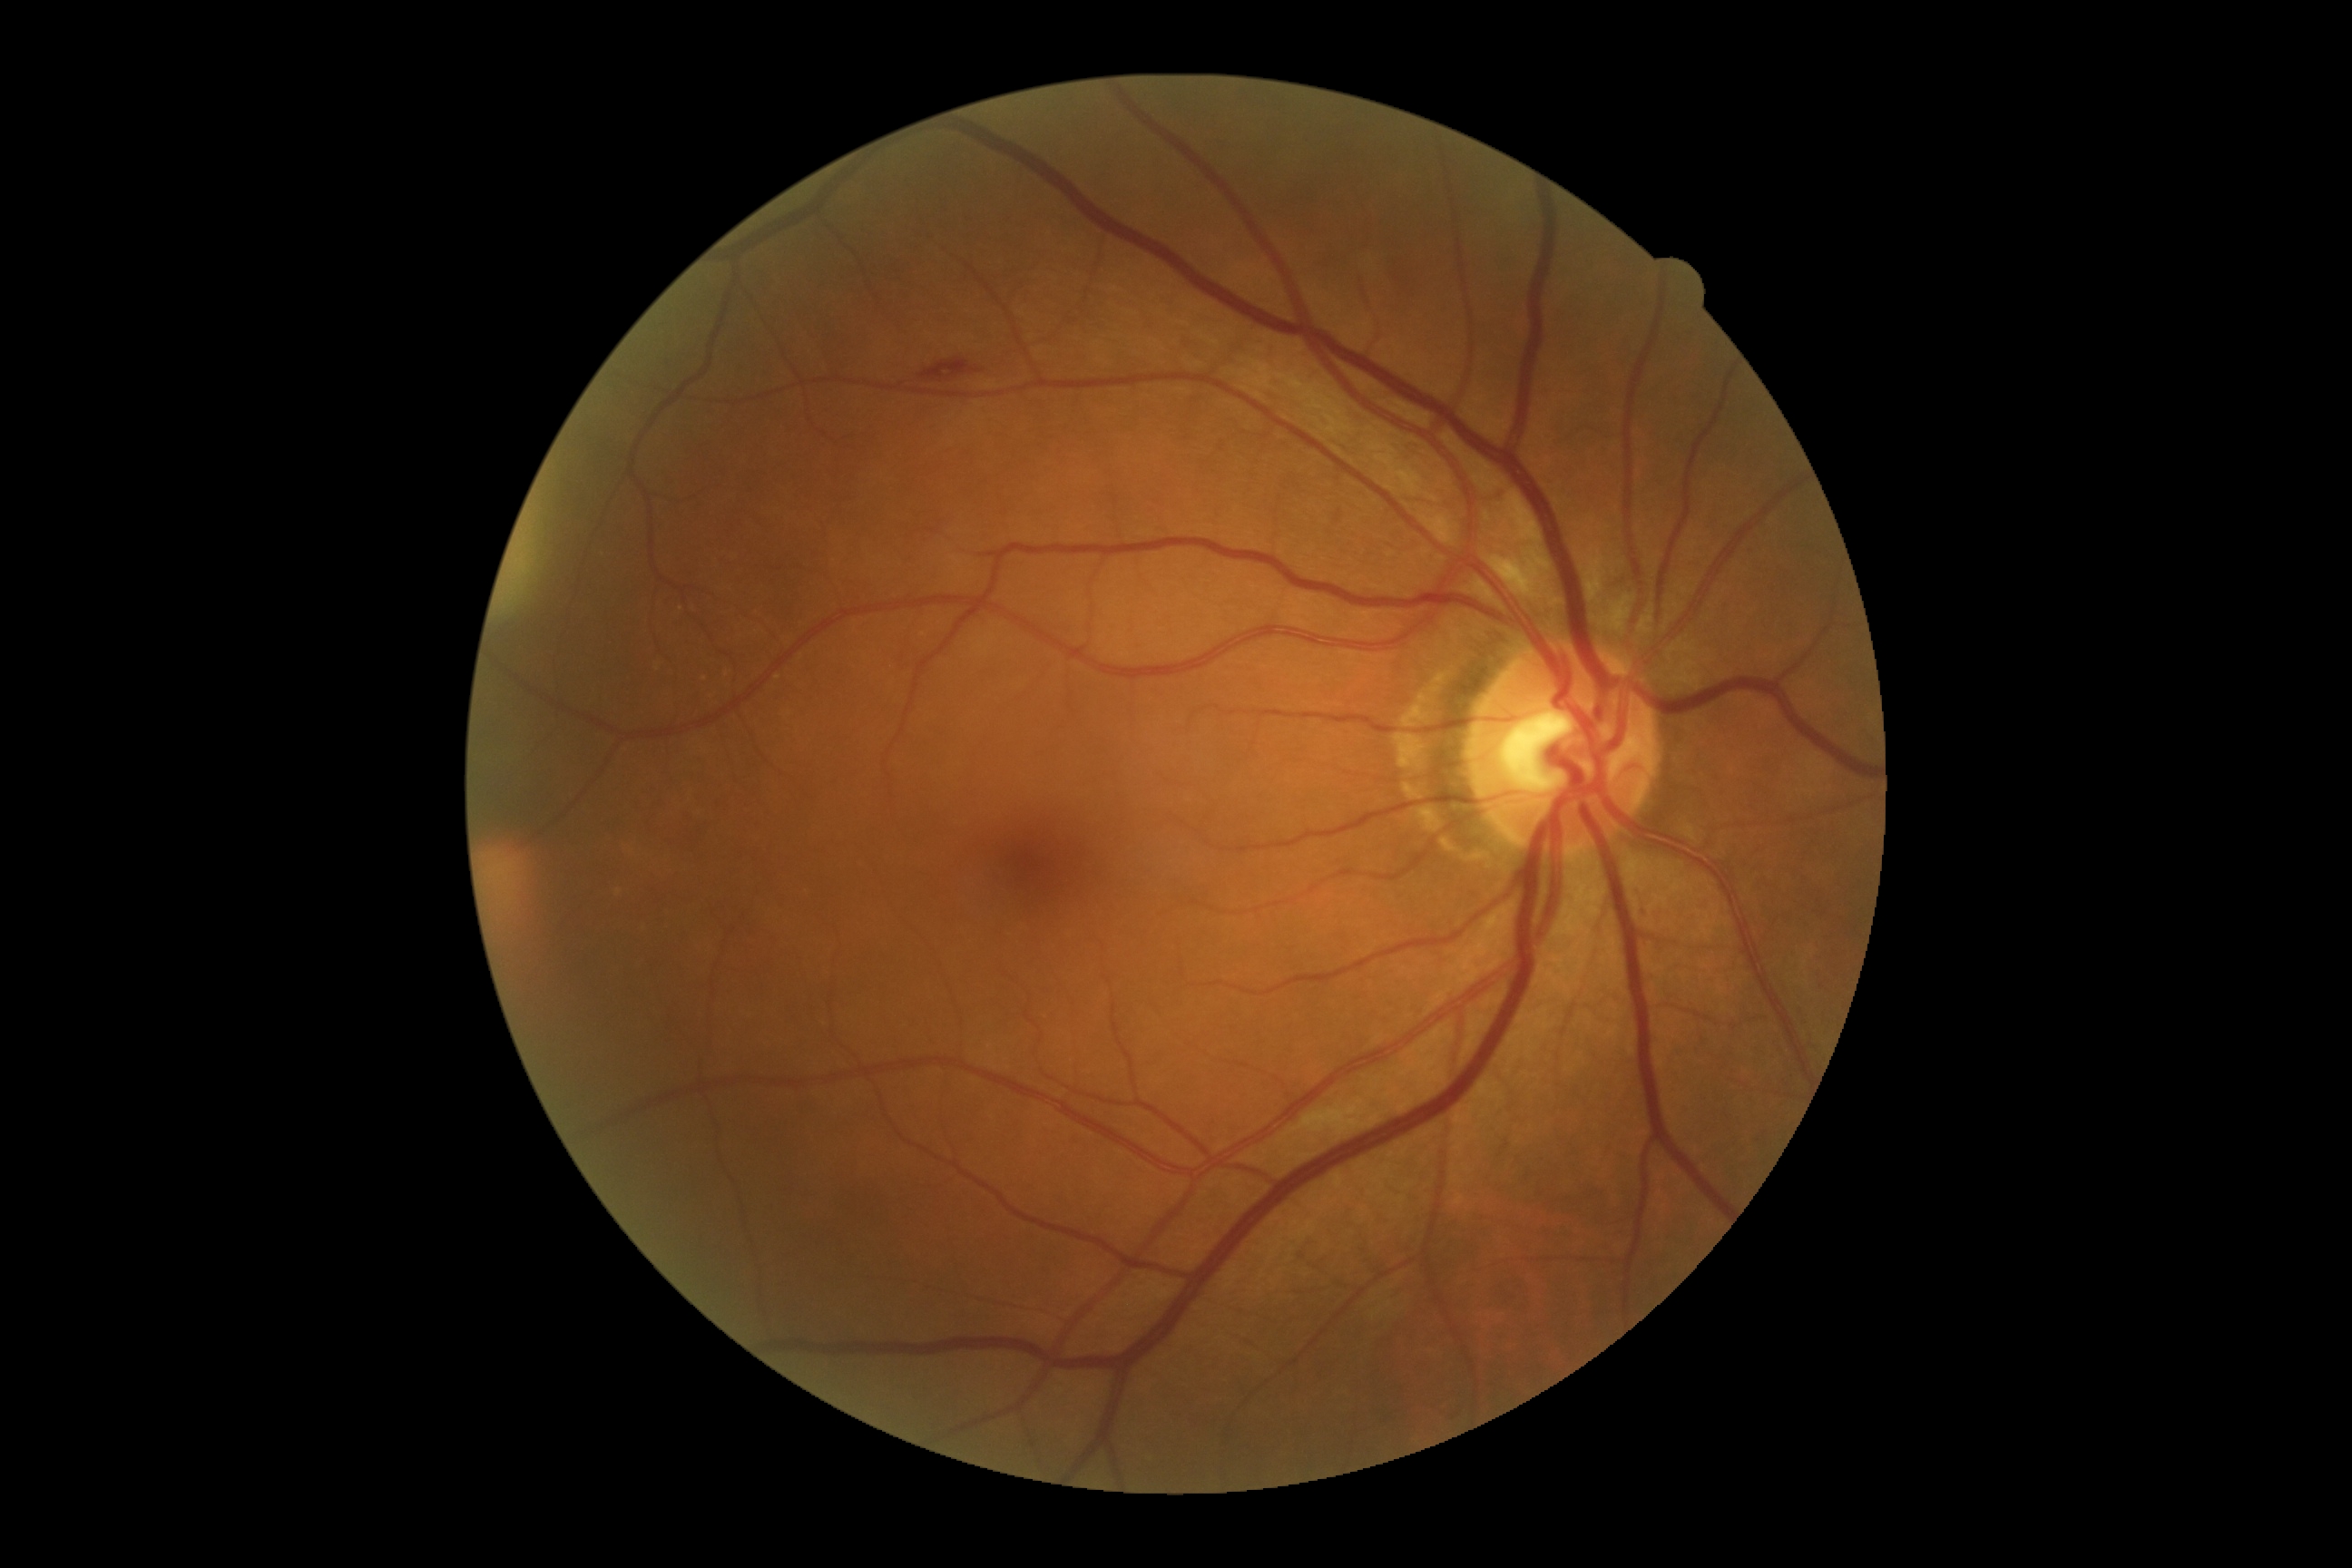 {
  "dr_grade": "grade 2 (moderate NPDR)"
}